1240 x 1240 pixels; infant wide-field fundus photograph
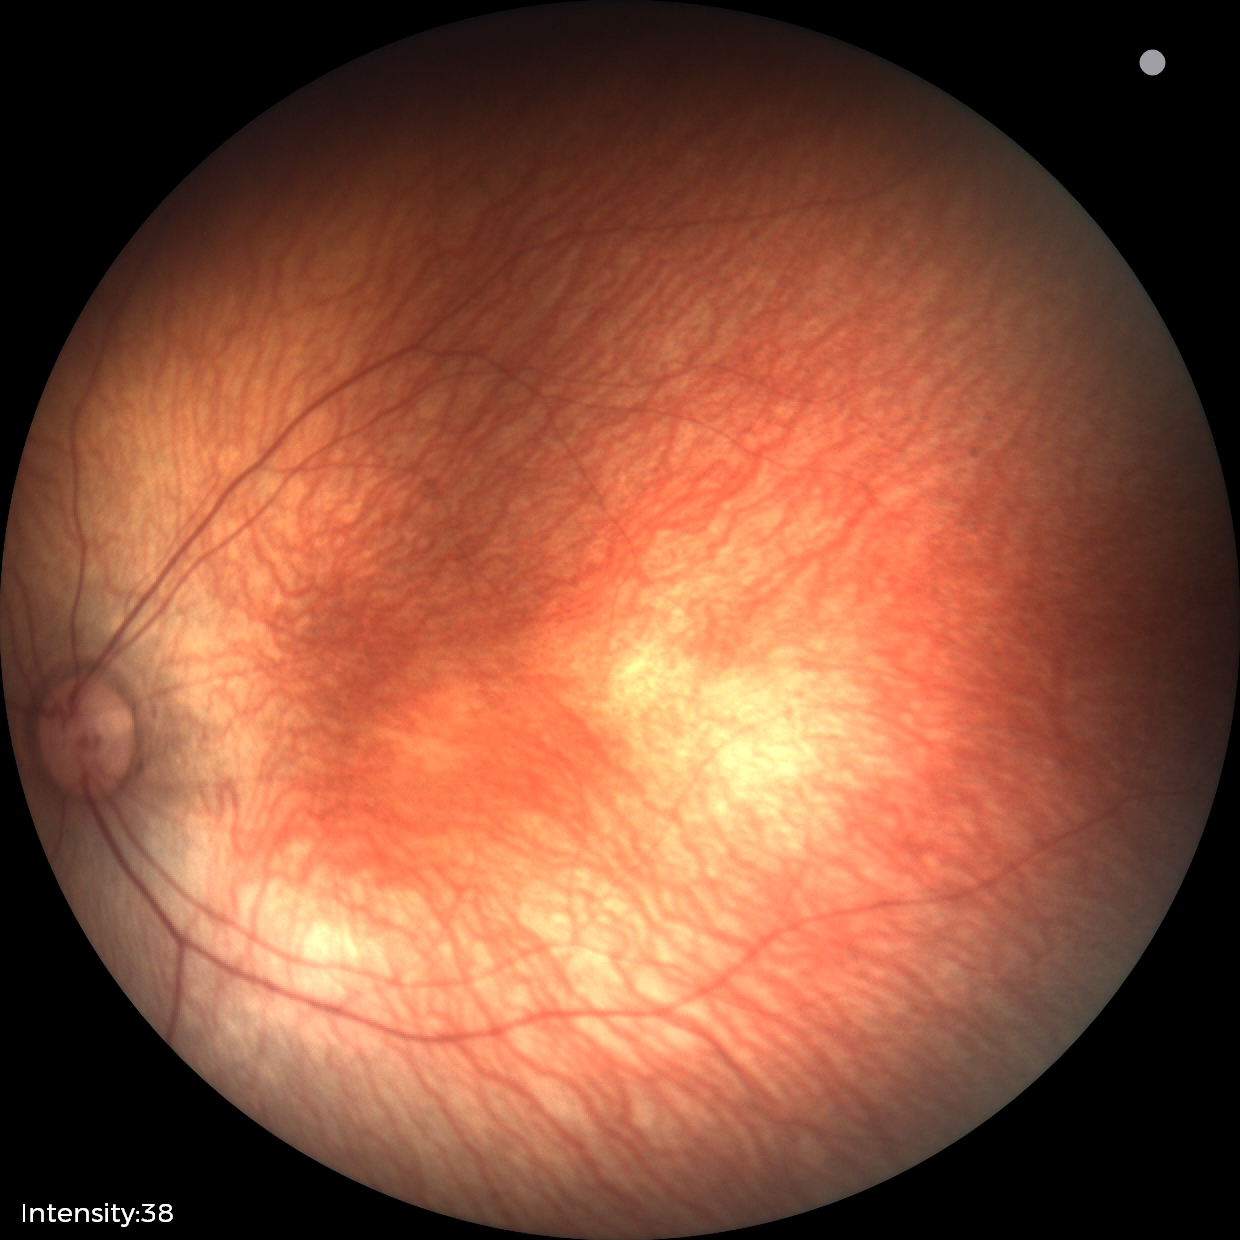

Impression: normal